FOV: 45 degrees, color fundus photograph, 2212x1659px: 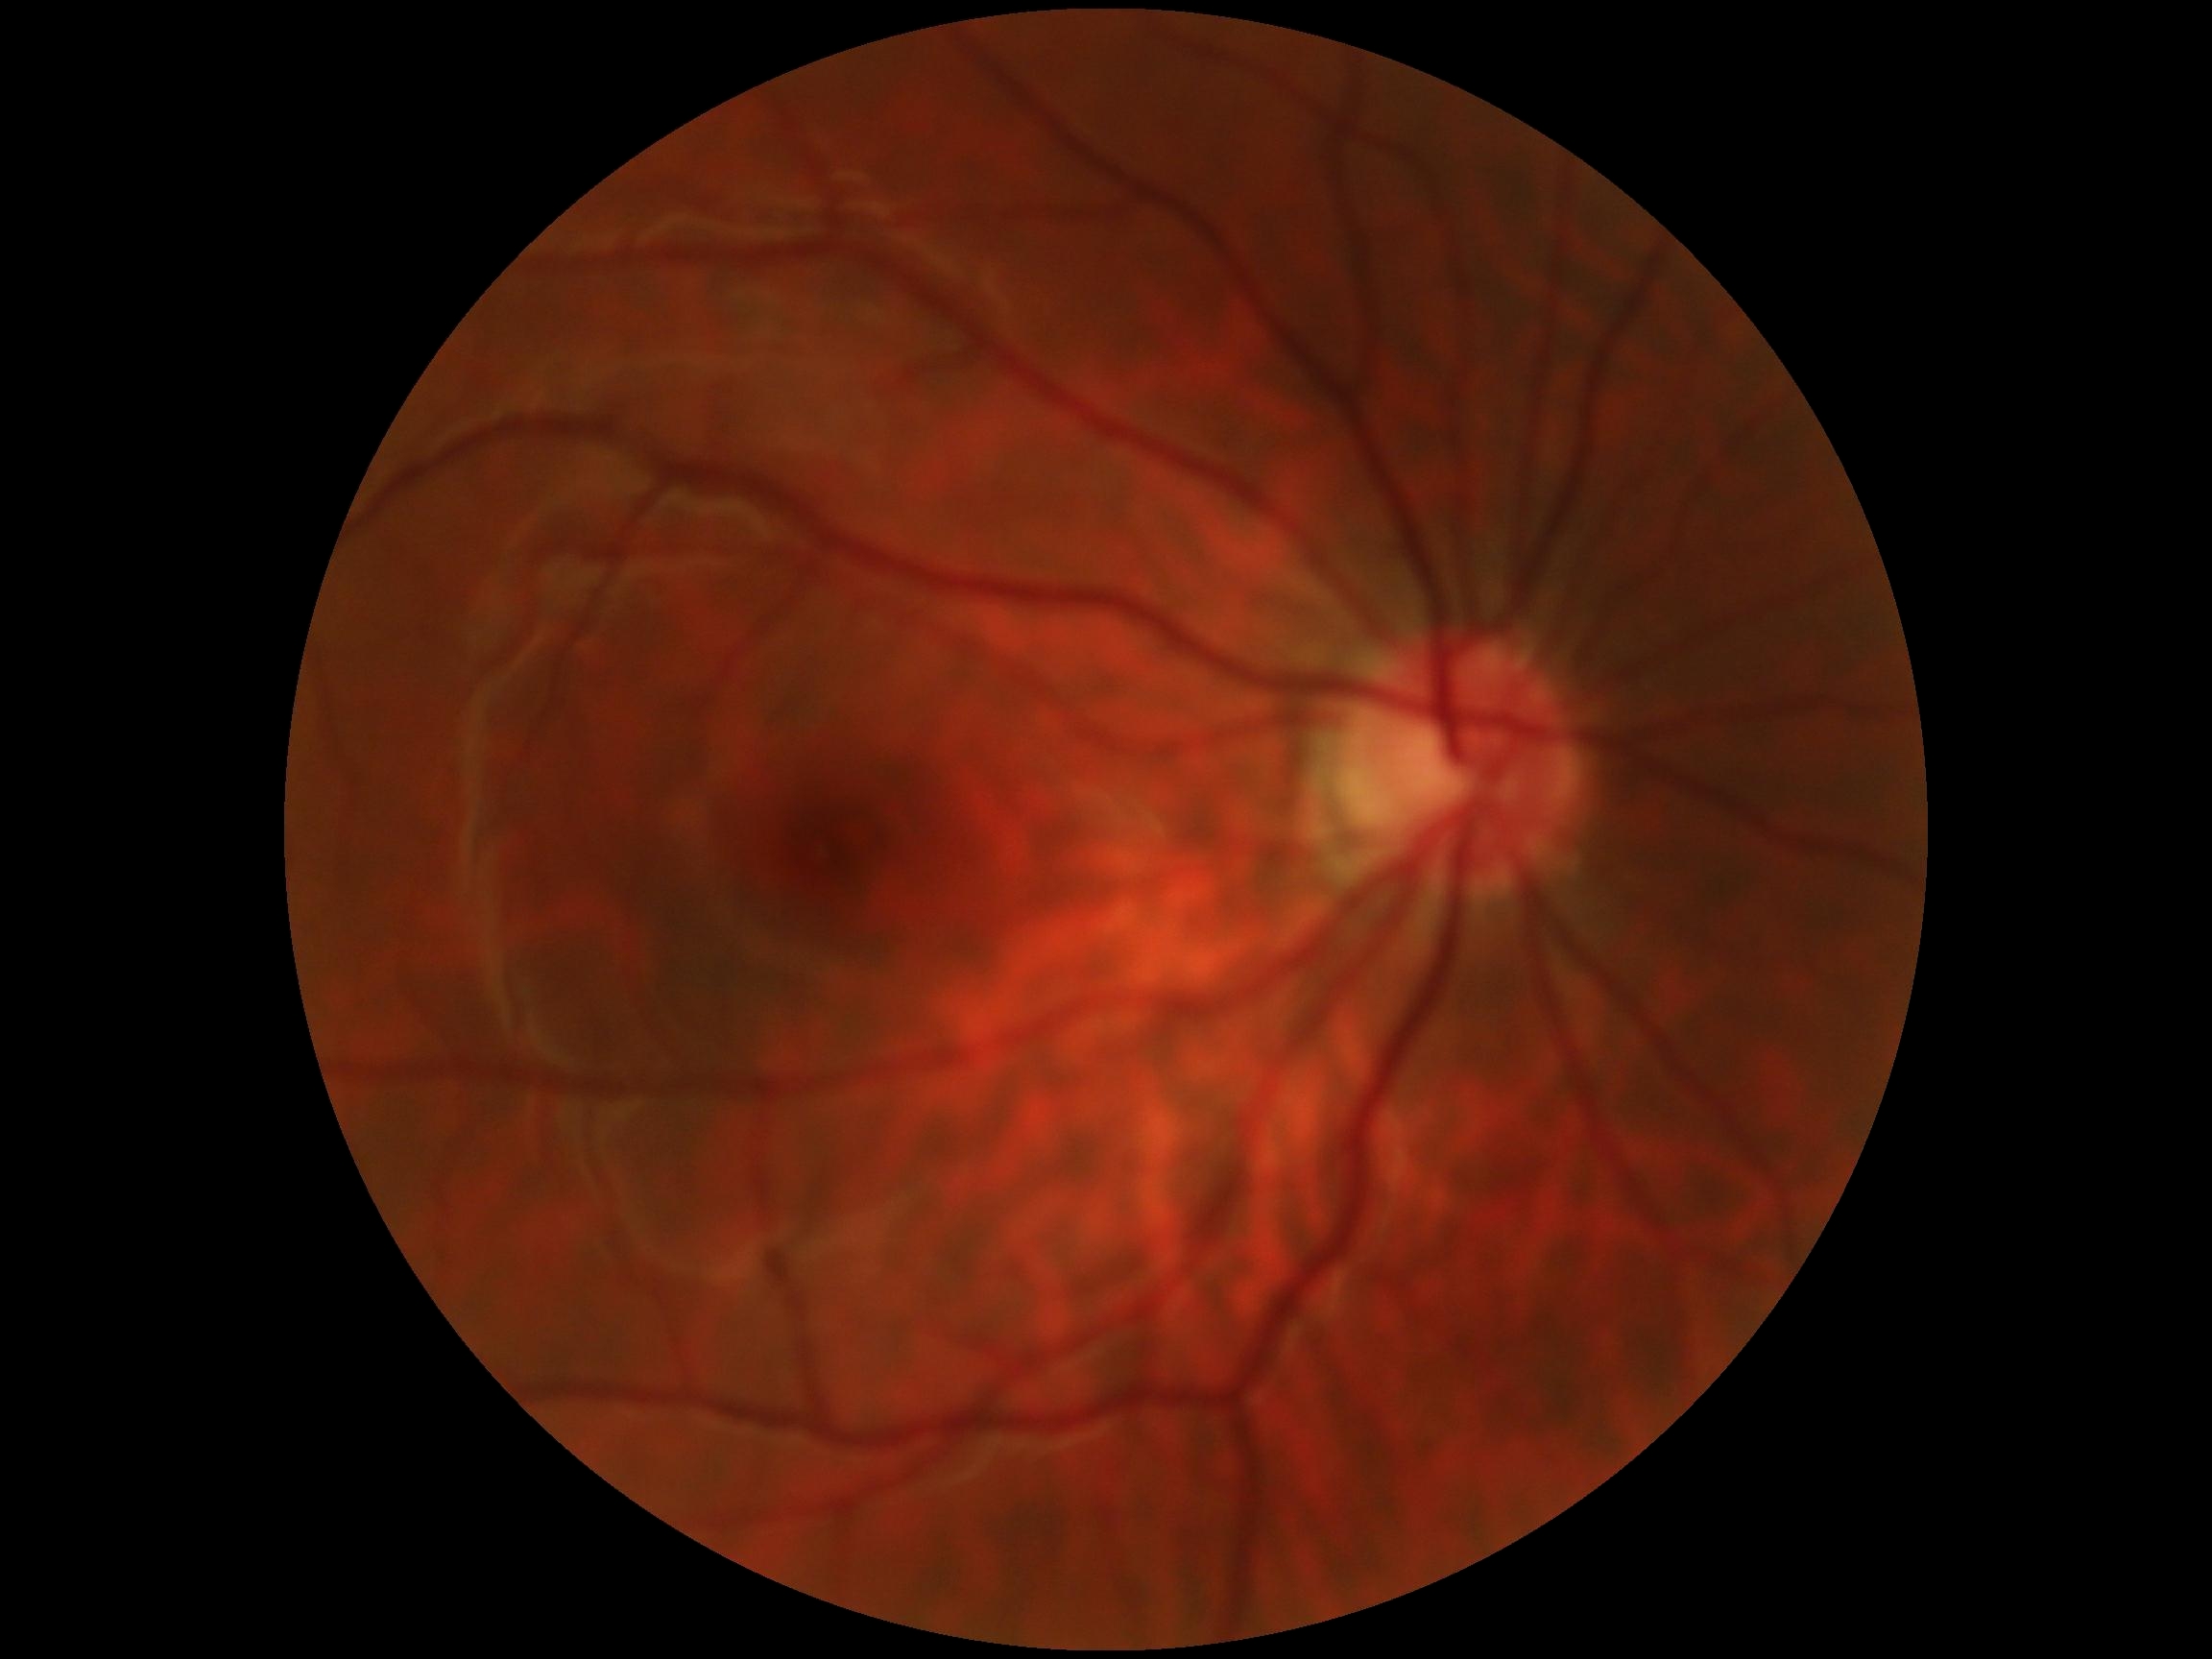

No apparent diabetic retinopathy. Diabetic retinopathy grade: no apparent retinopathy (0) — no visible signs of diabetic retinopathy.